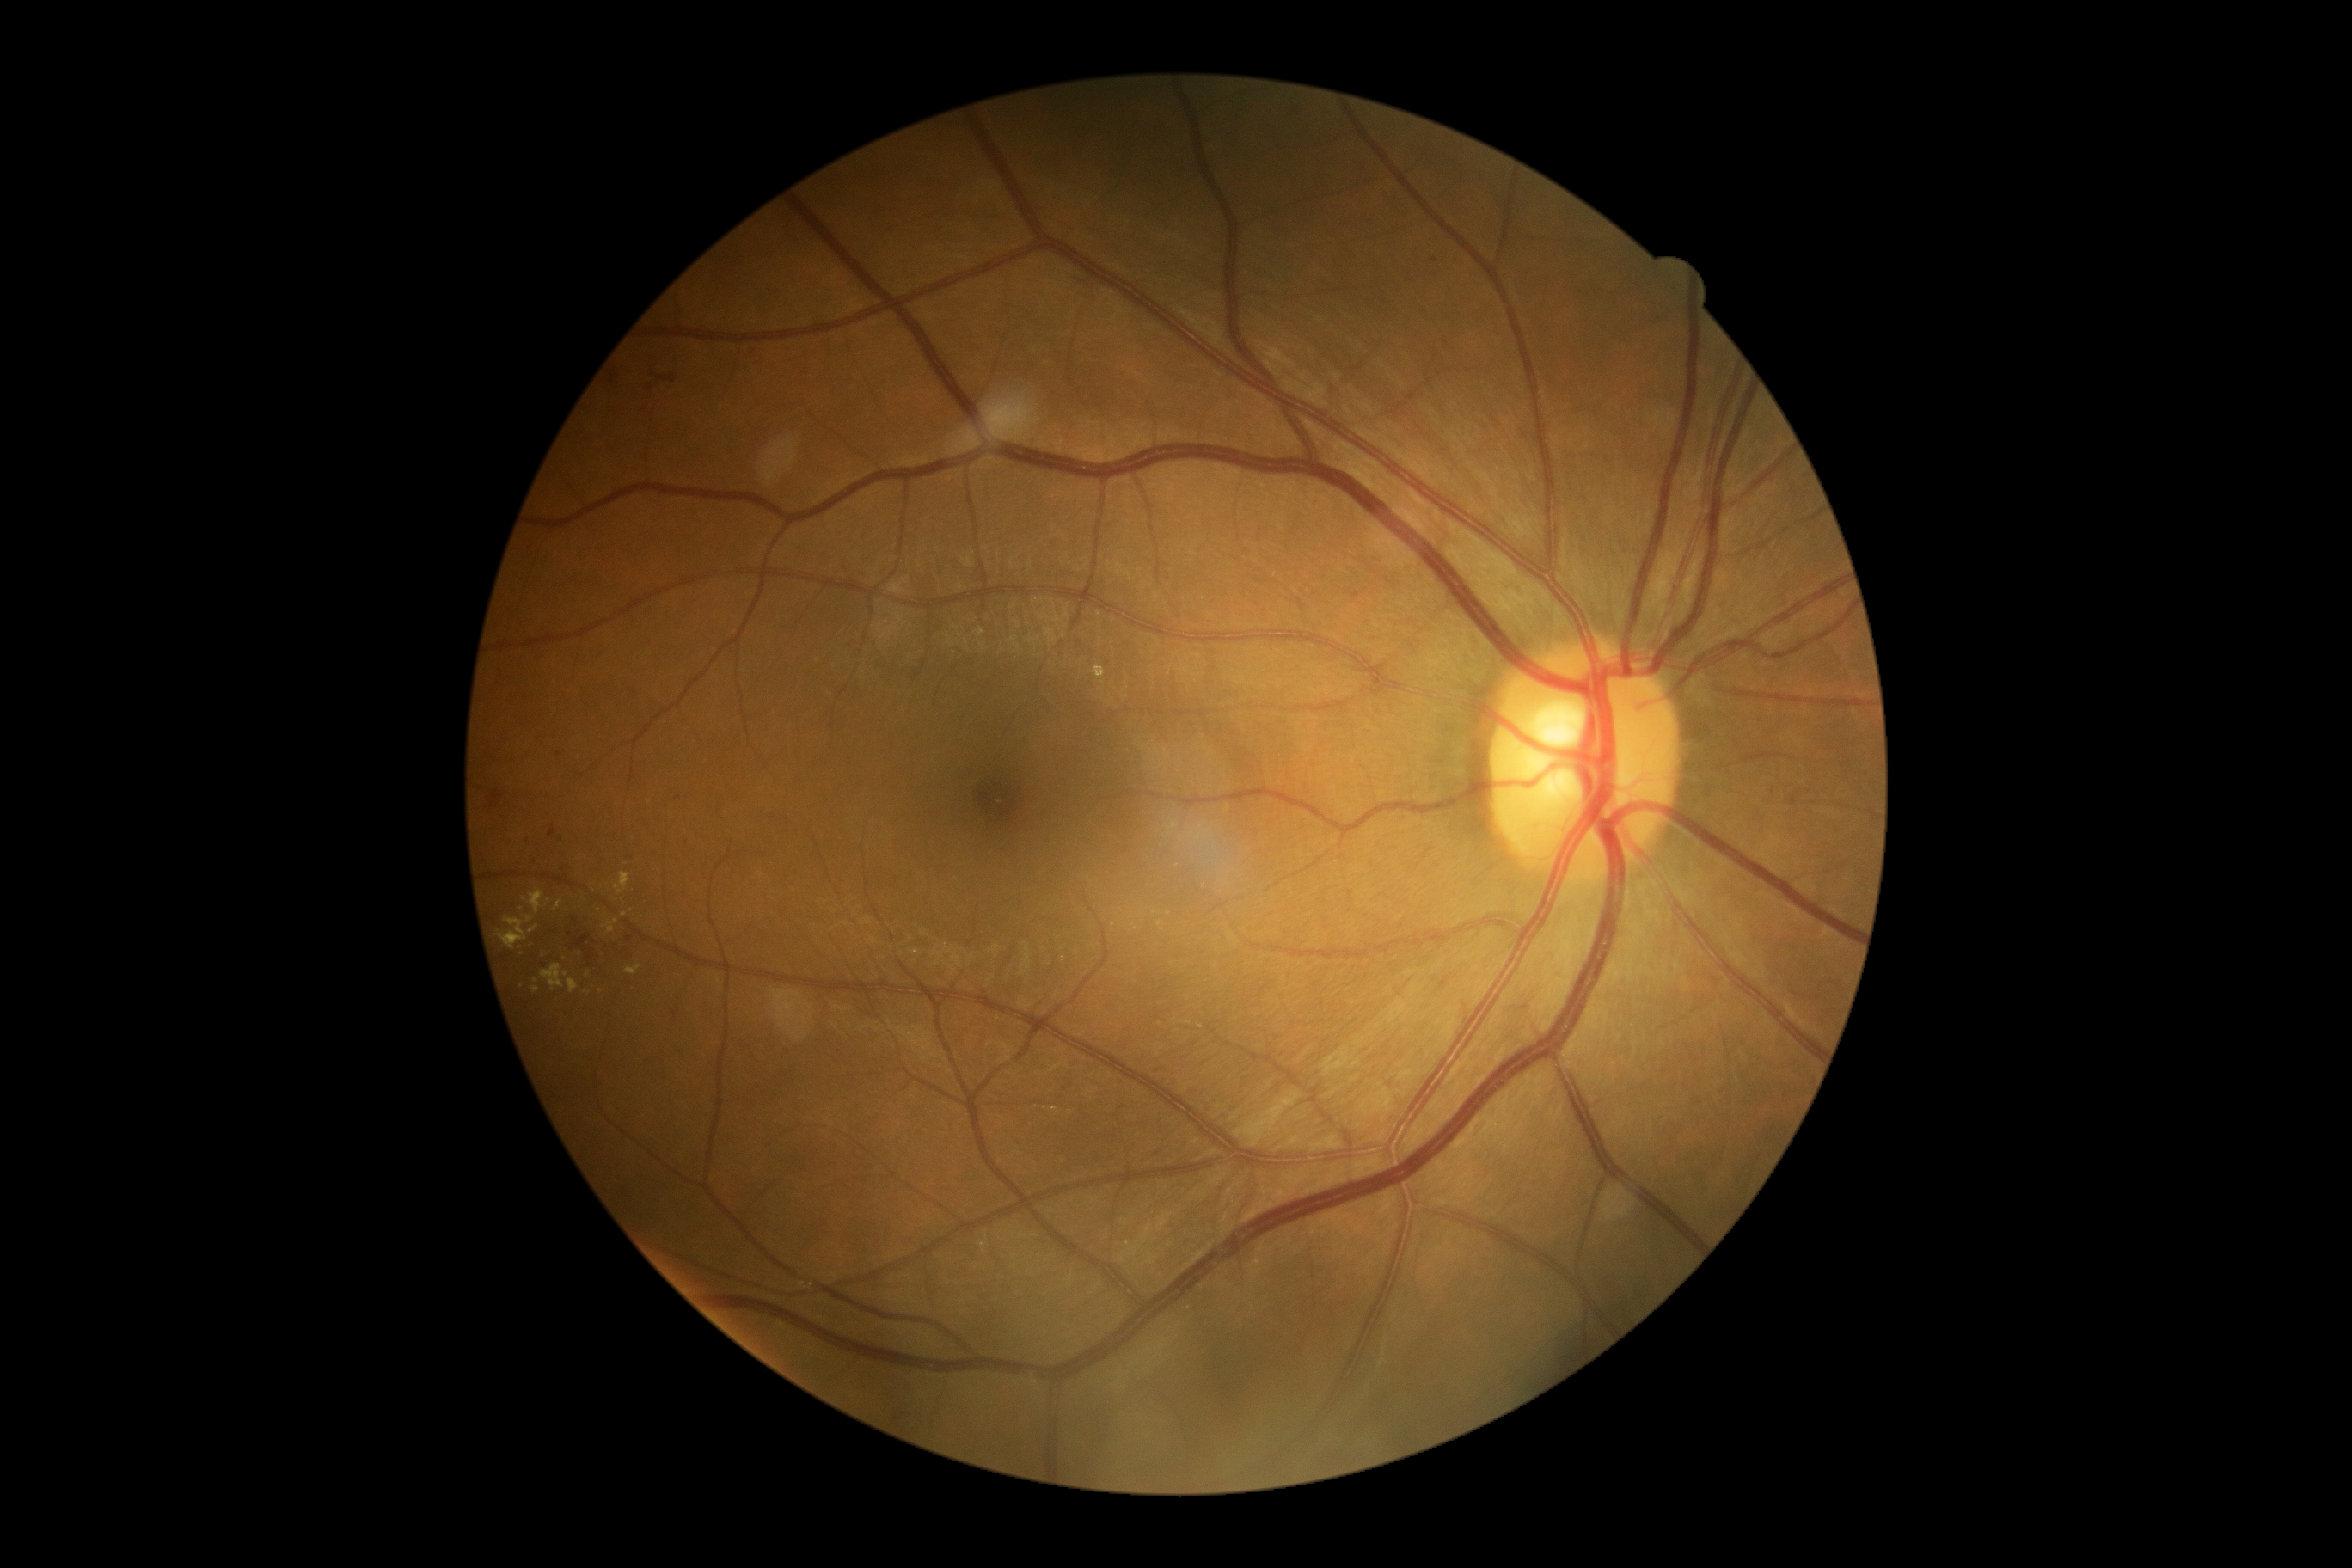
retinopathy grade=2 (moderate NPDR).